Infant wide-field fundus photograph
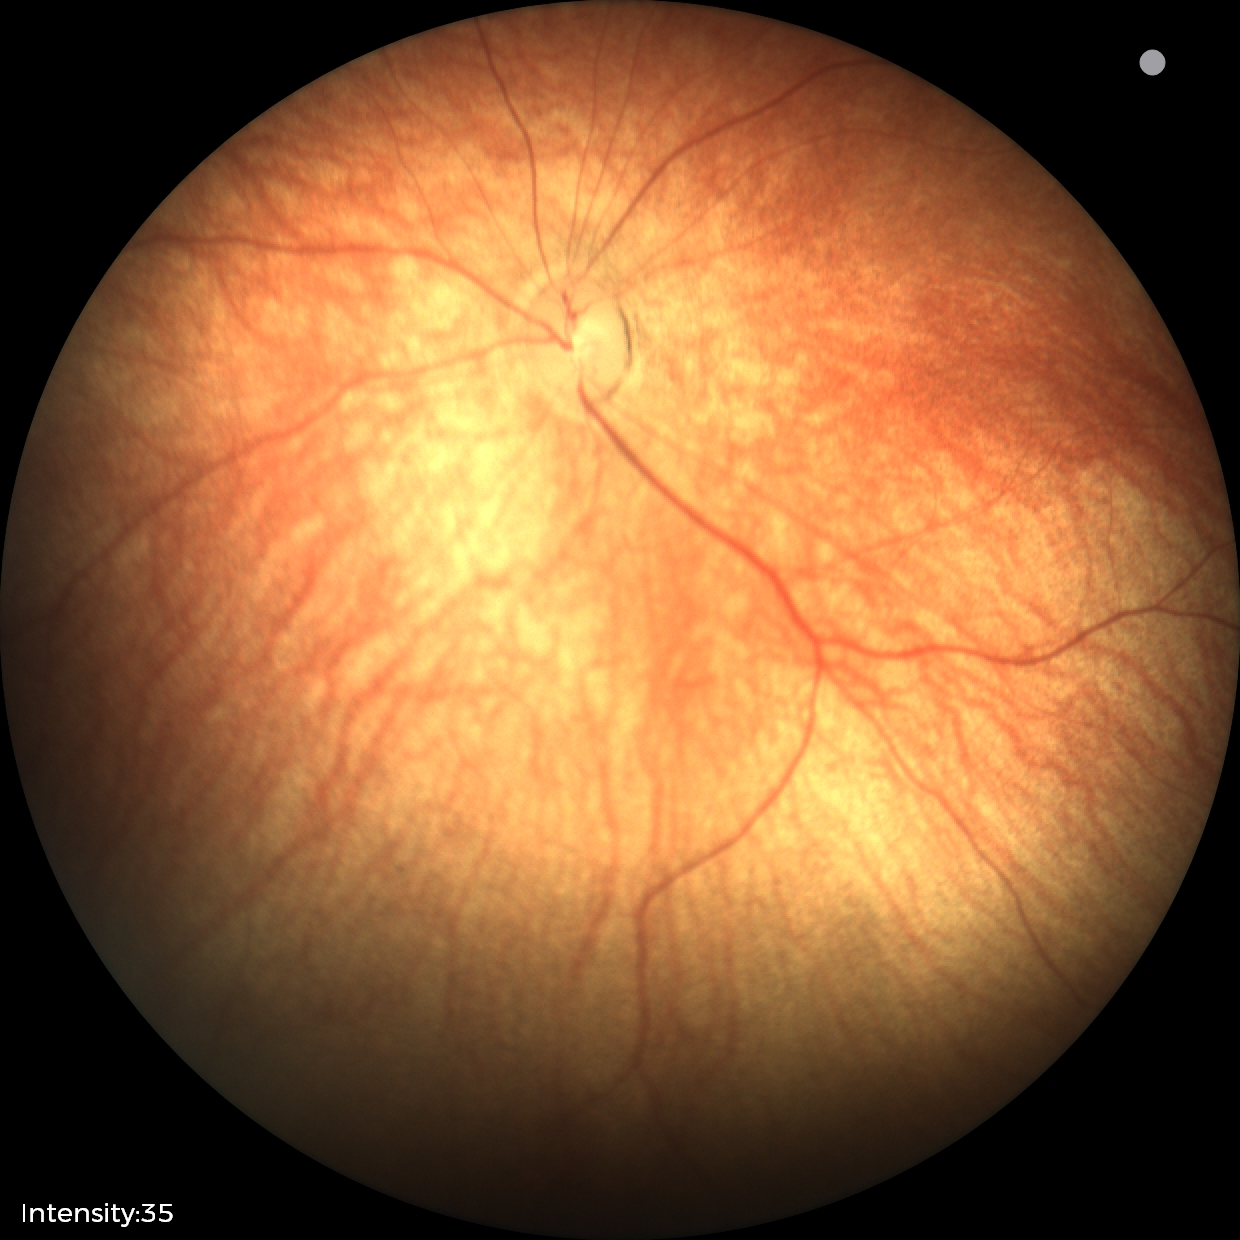 Series diagnosed as retinal hemorrhages.